2352x1568.
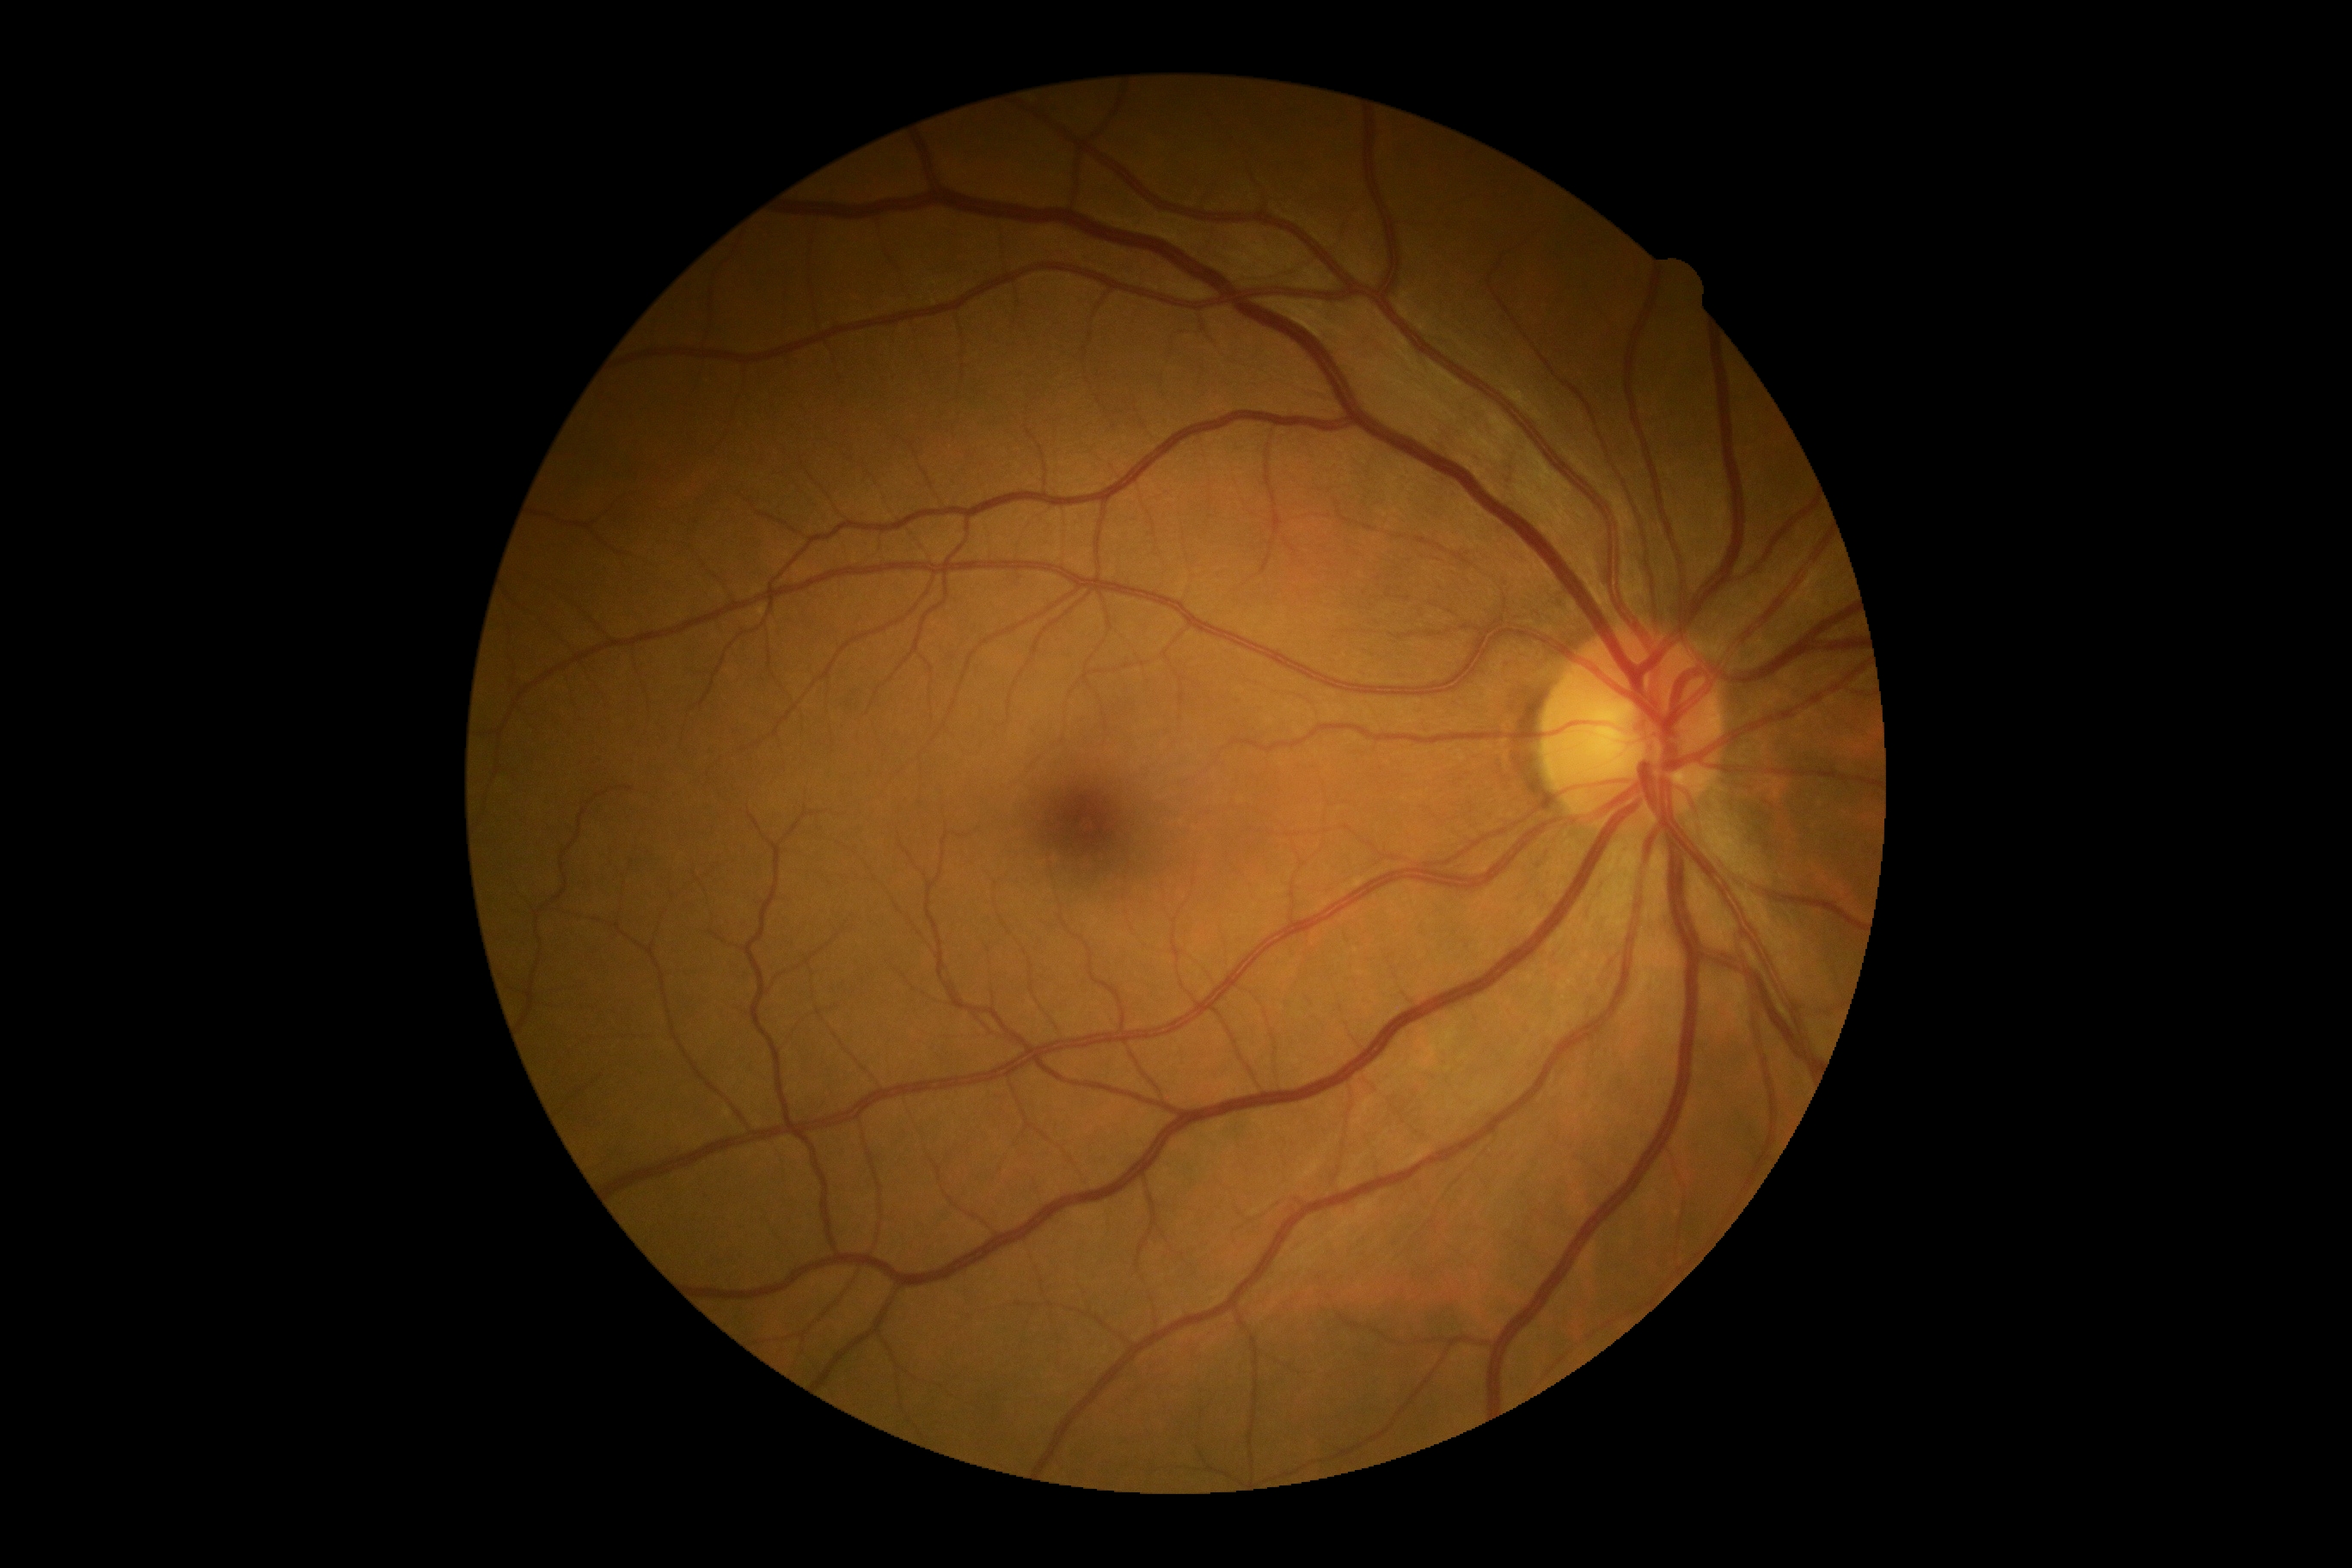 Retinopathy is no apparent retinopathy (grade 0). No apparent diabetic retinopathy.